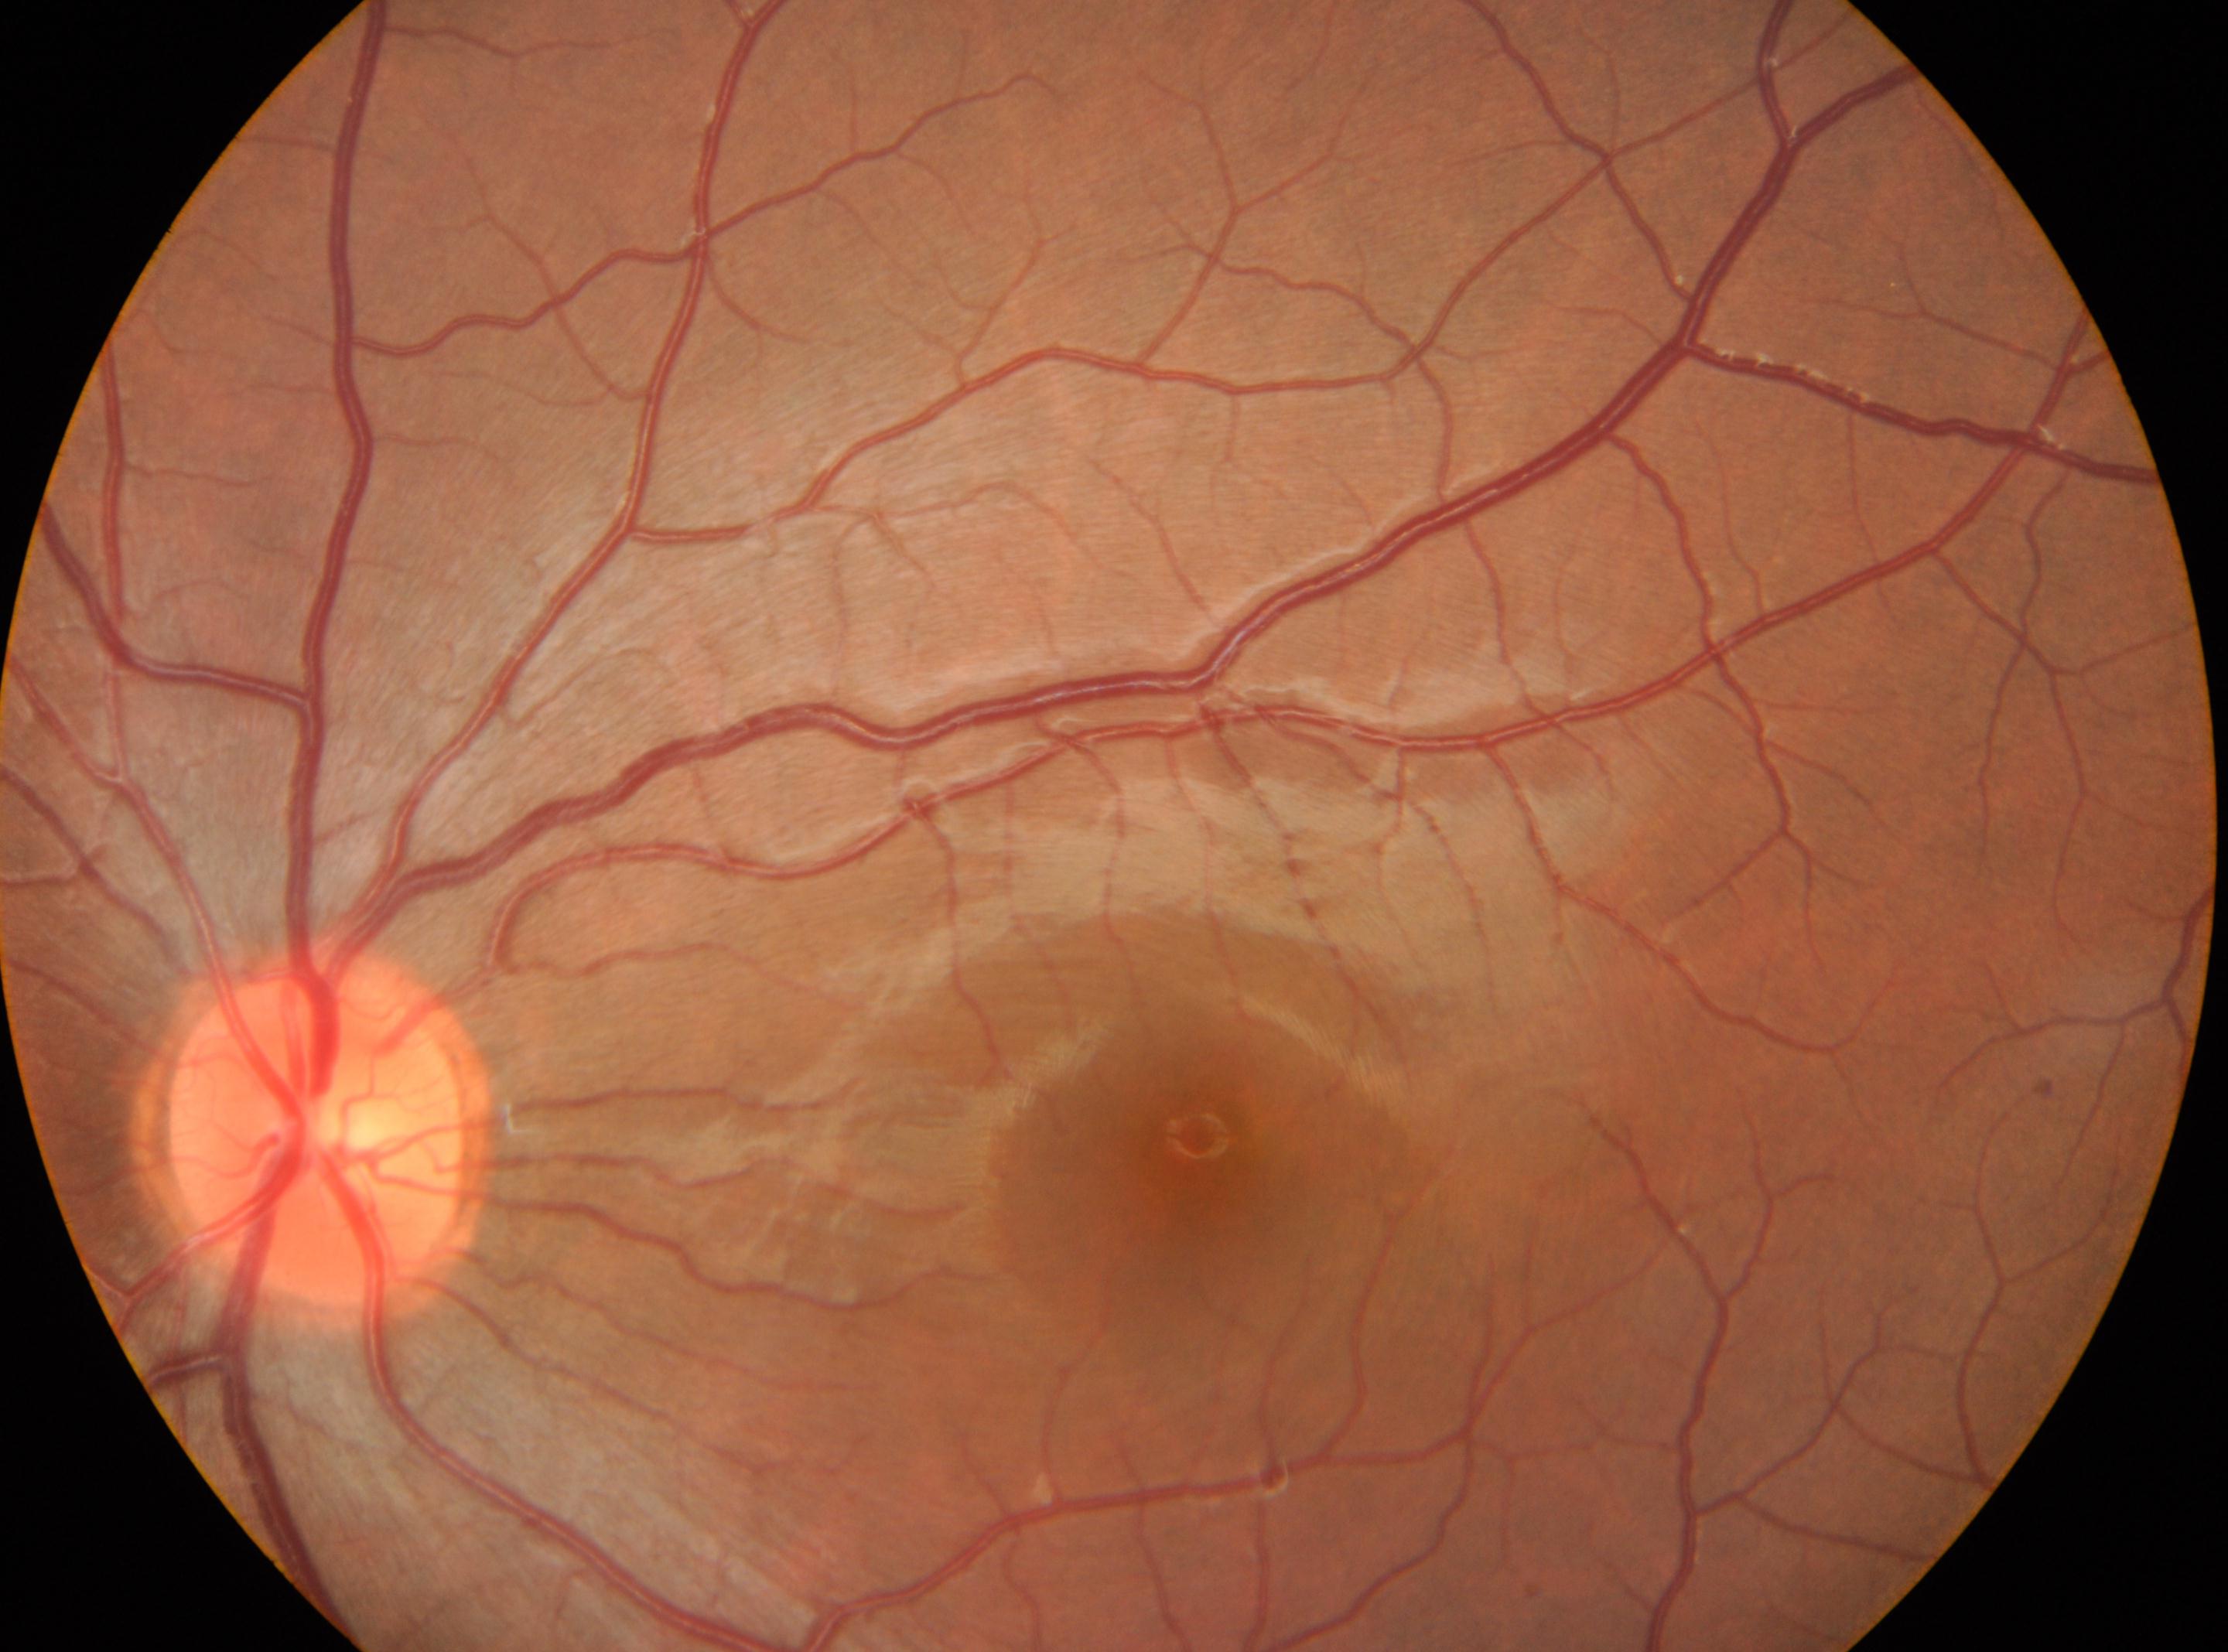
diabetic retinopathy grade: no apparent diabetic retinopathy (0) | fovea center: [1202, 1169] | the optic disc: [317, 1142] | laterality: the left eye | DR impression: No signs of diabetic retinopathy.